NIDEK AFC-230 fundus camera; posterior pole photograph.
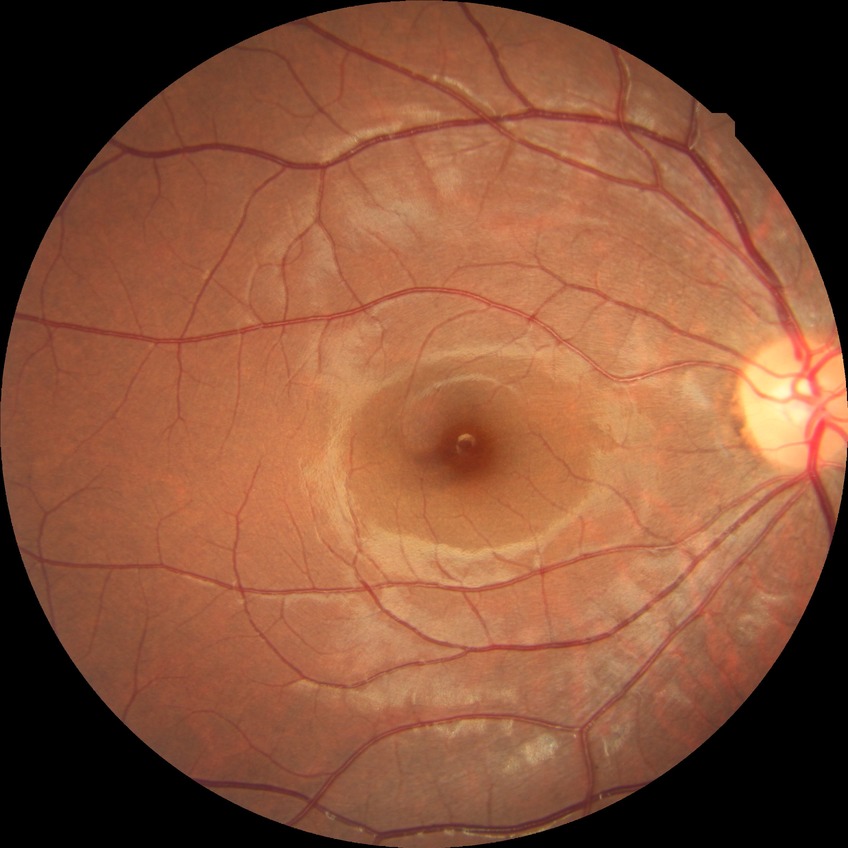 No DR findings. Davis DR grade: NDR.